2352 x 1568 pixels. 45° field of view — 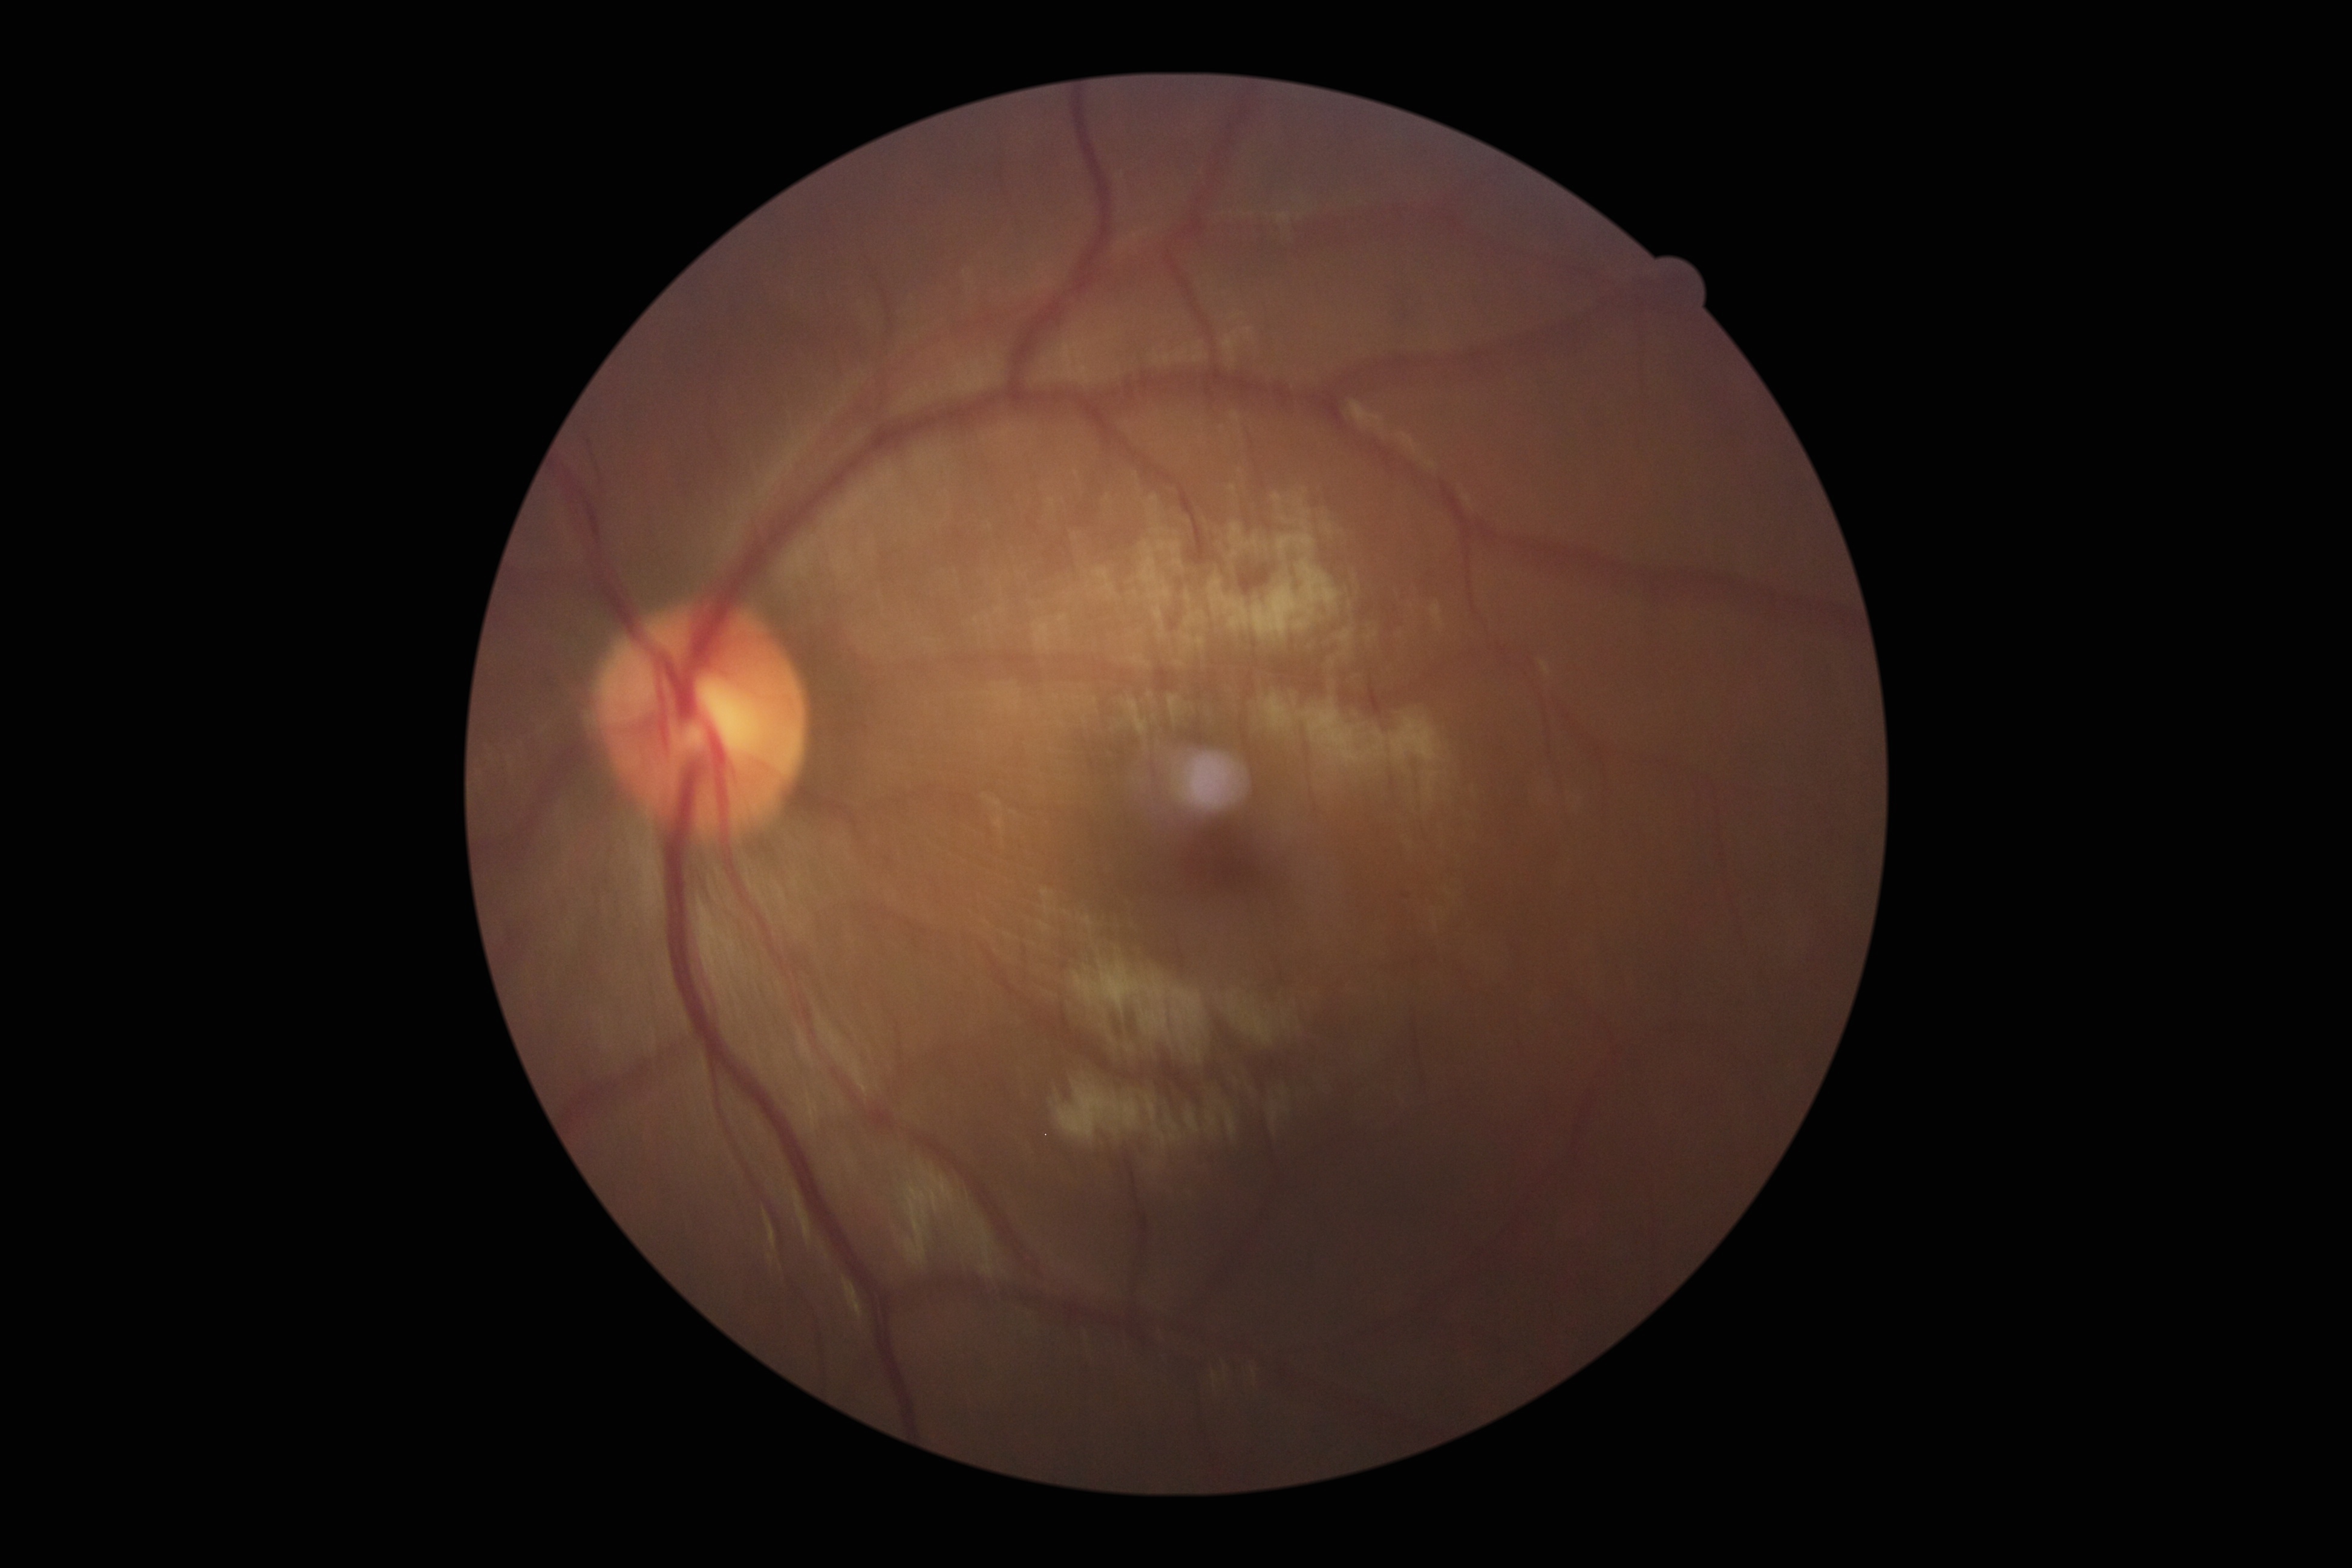

Retinopathy grade: 0 (no apparent retinopathy).
No diabetic retinal disease findings.